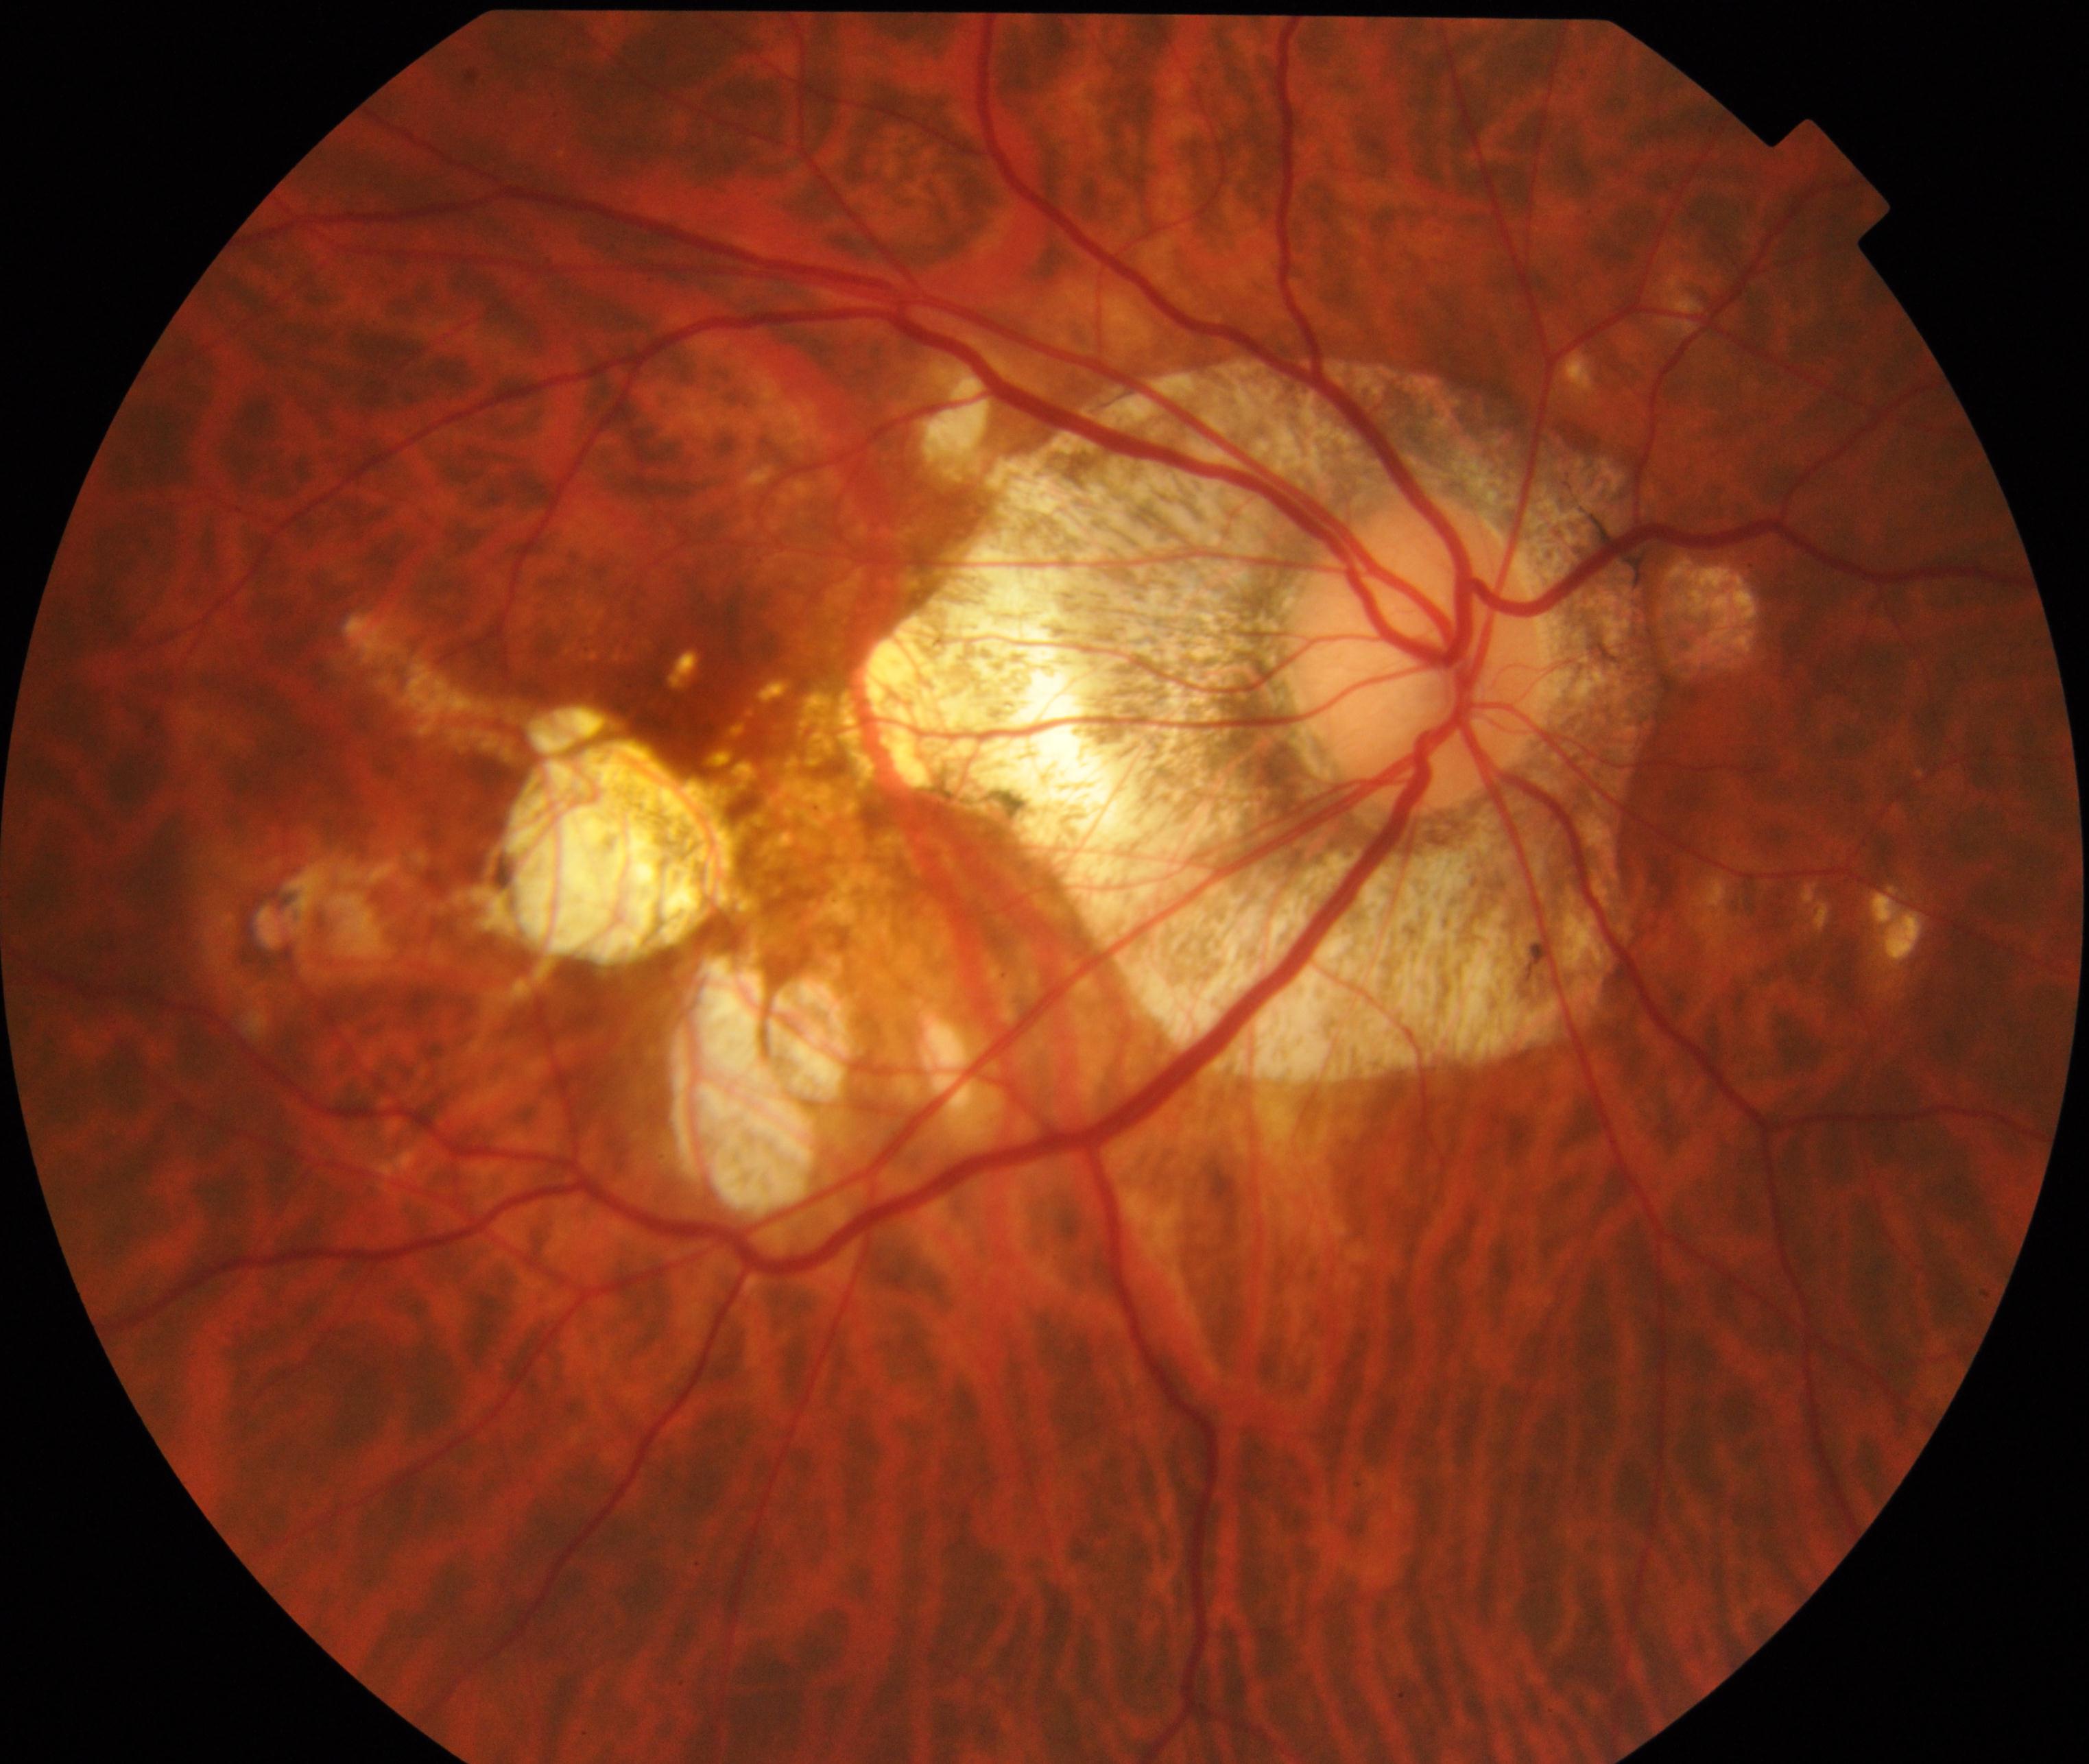 Classification: pathological myopia.